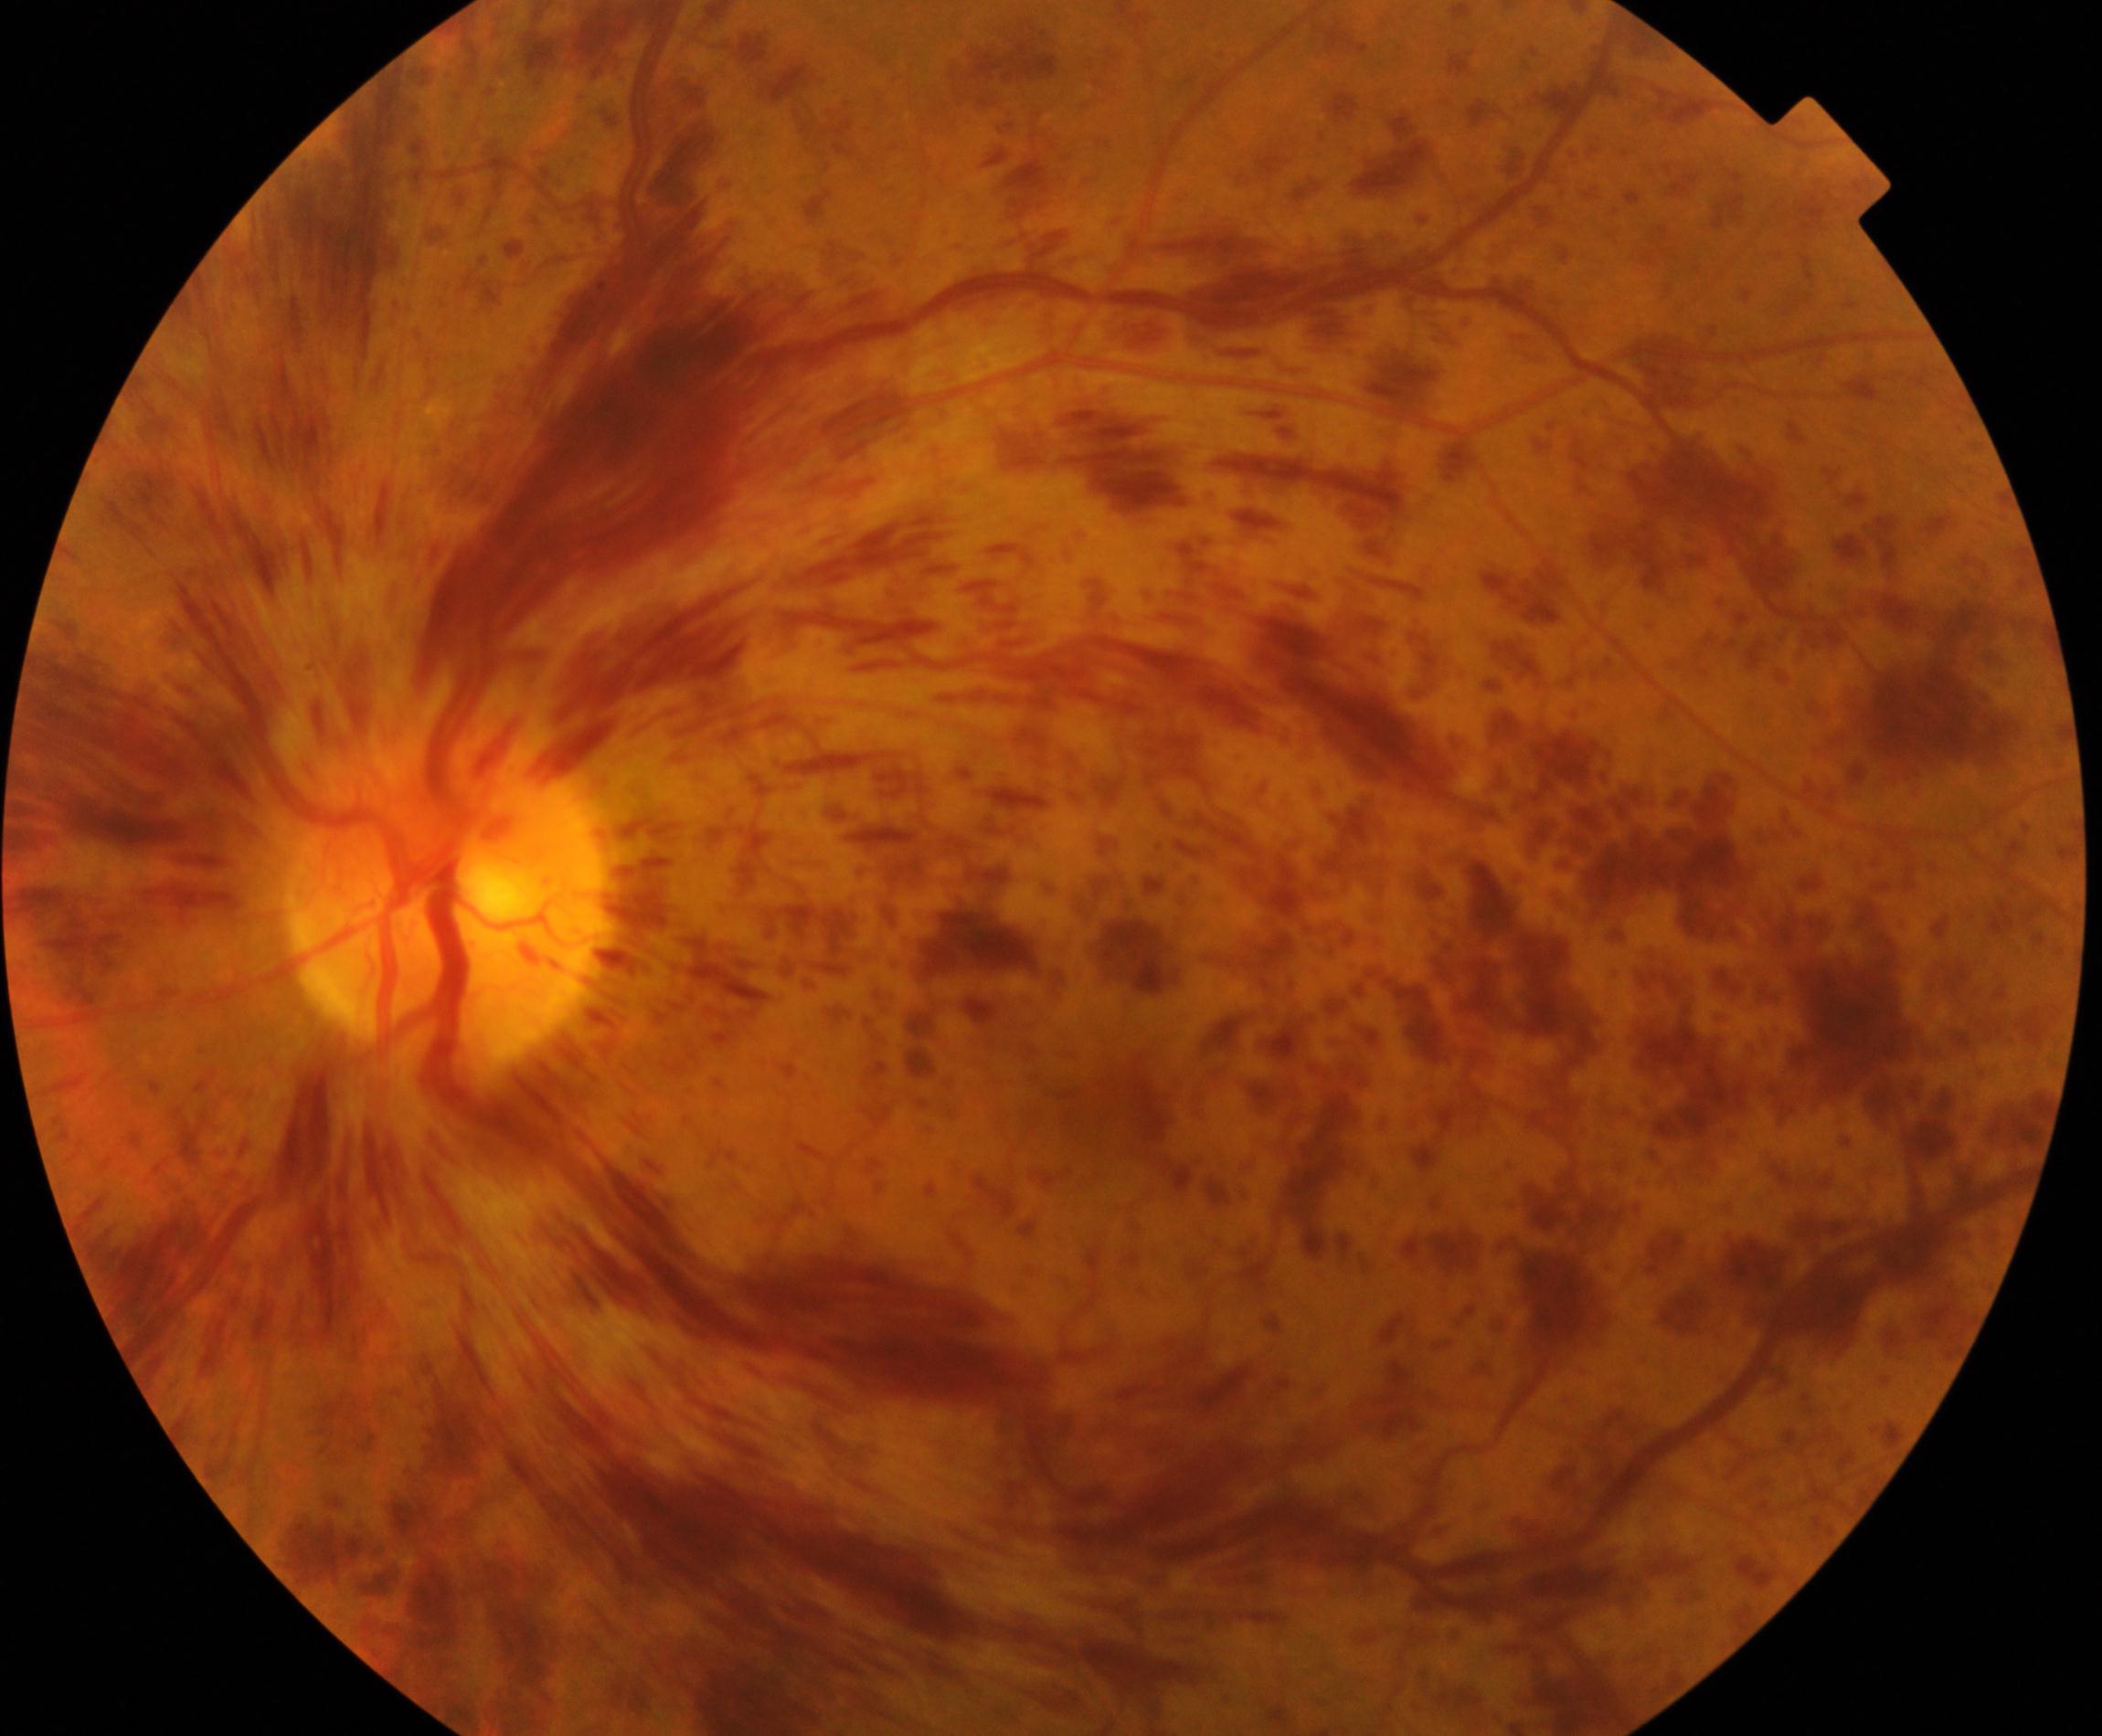
Appearance consistent with central retinal vein occlusion.